2361x1568, mydriatic (tropicamide 0.5%), retinal fundus photograph.
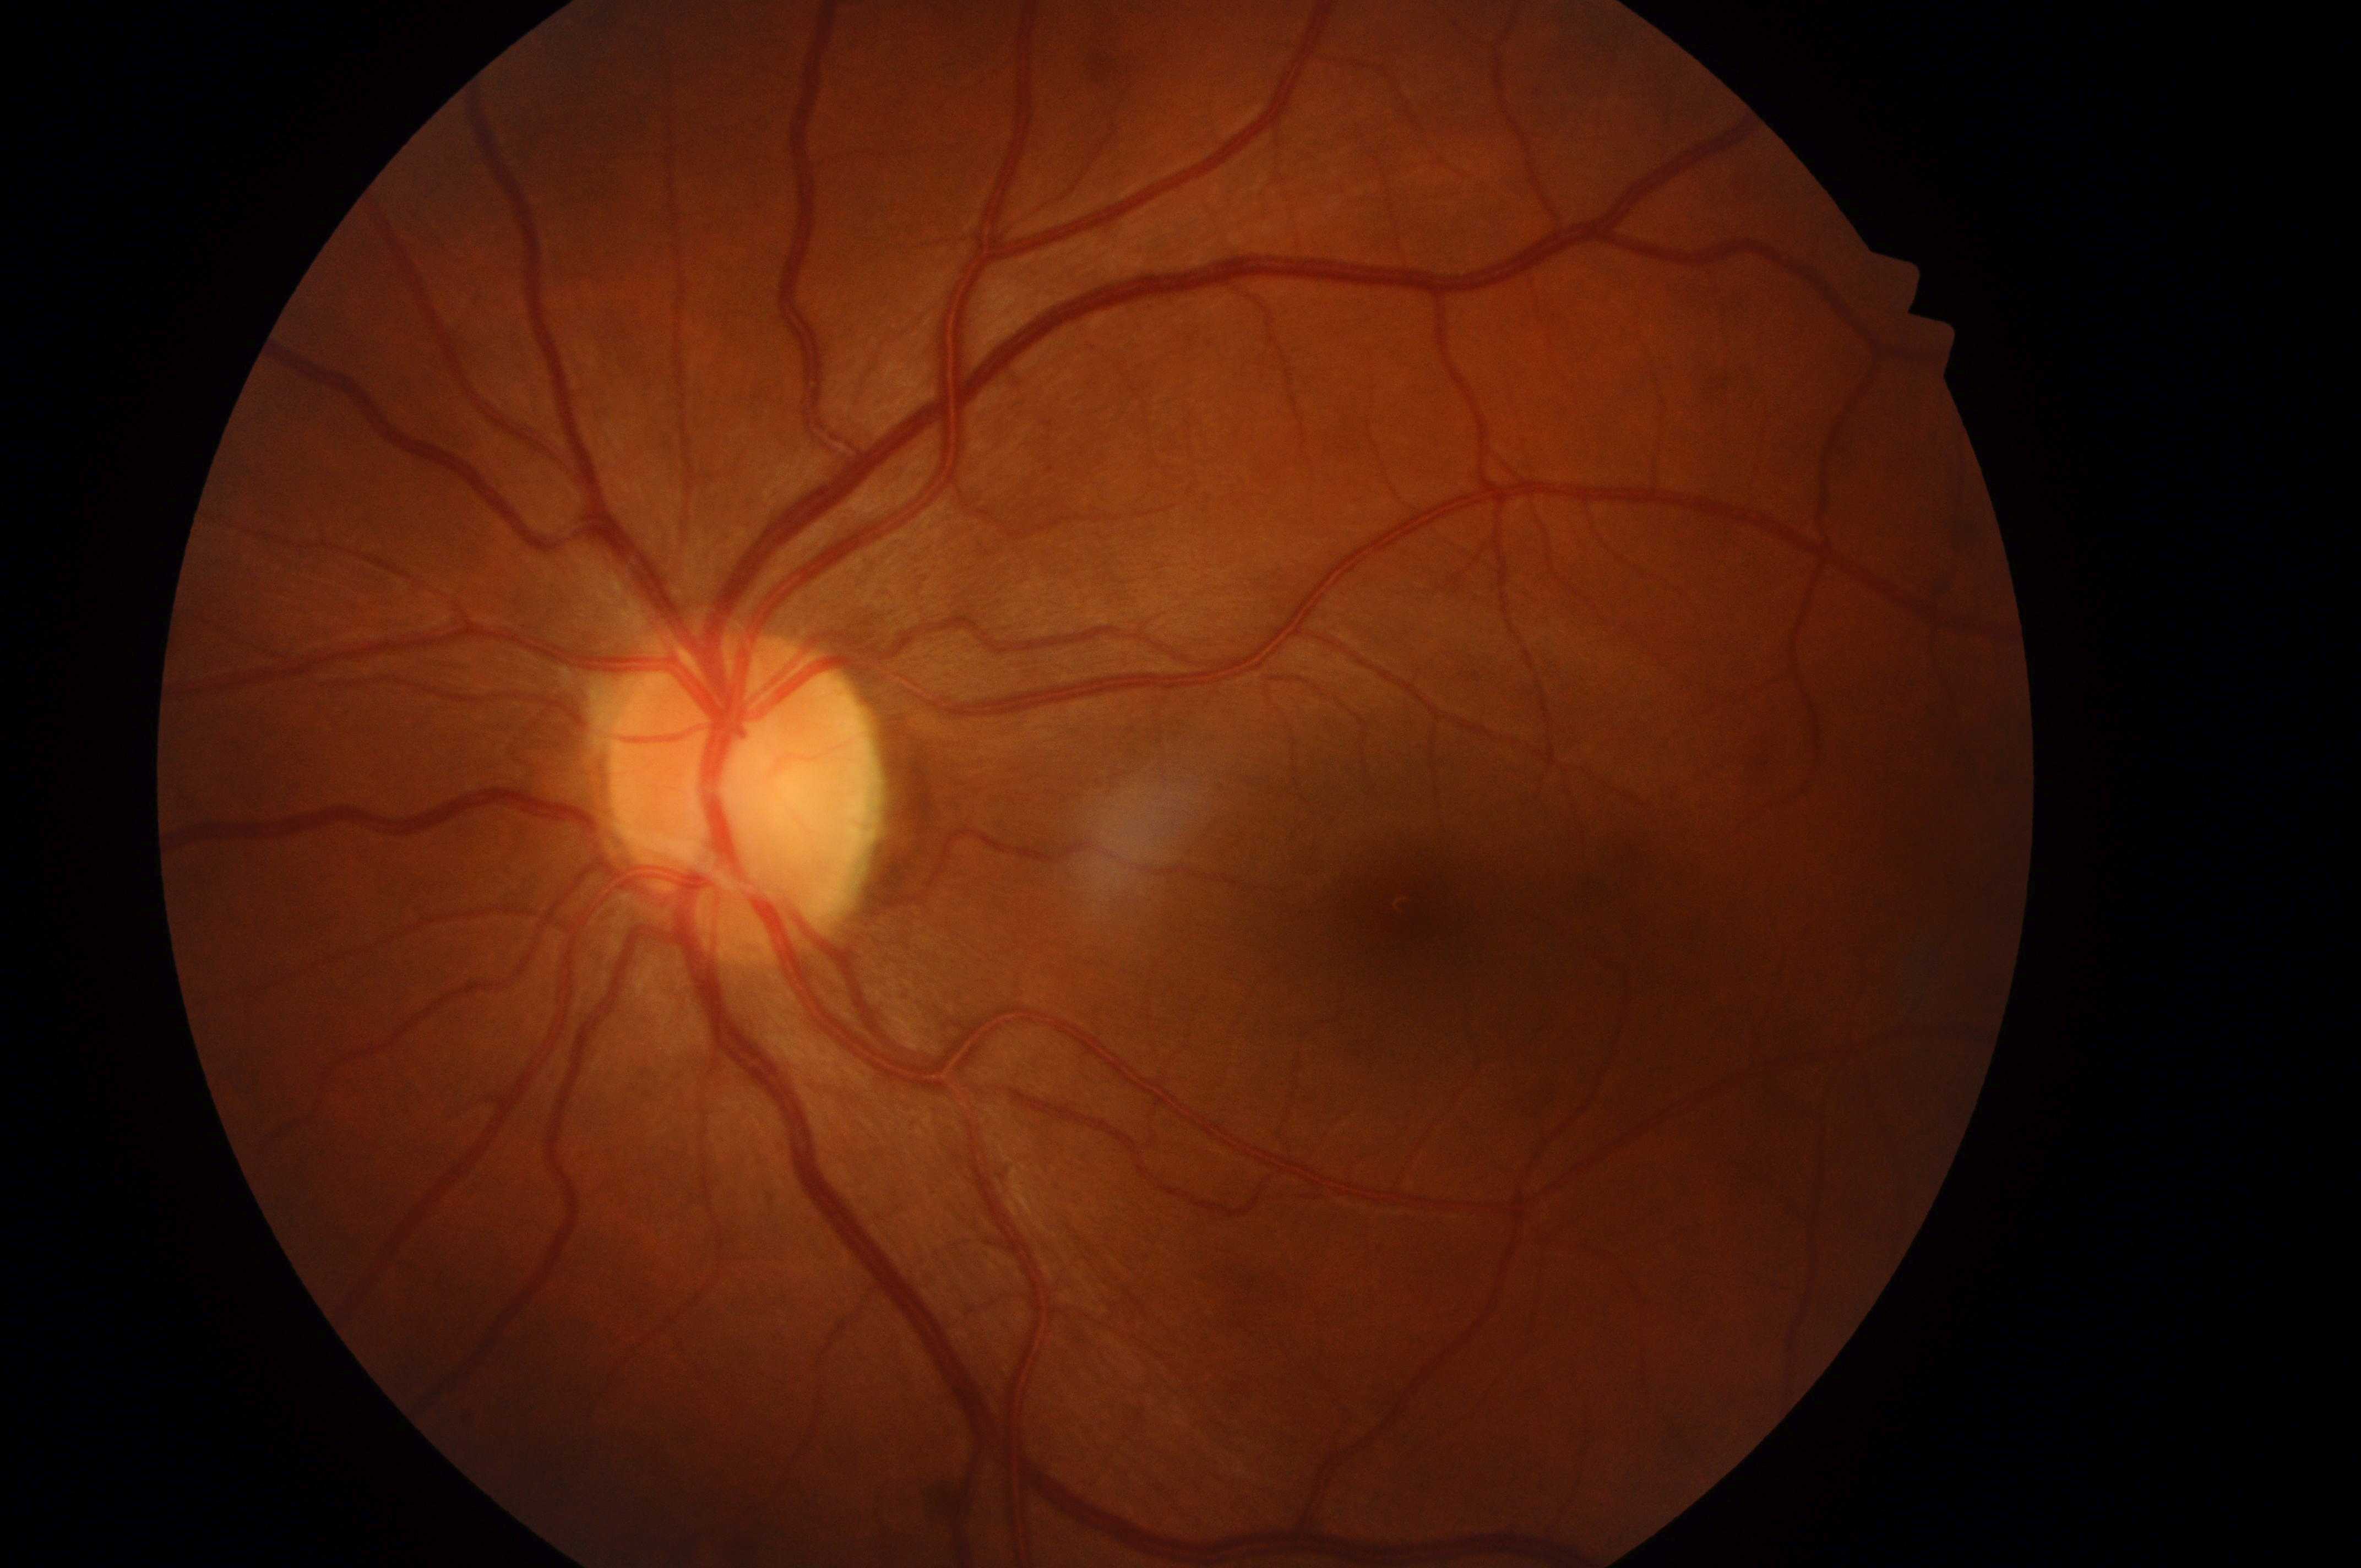

fovea centralis@(1434,919); oculus sinister; diabetic retinopathy (DR)@grade 0 (no apparent retinopathy); diabetic macular edema (DME)@grade 0 (no risk); the optic disc@(736,804).